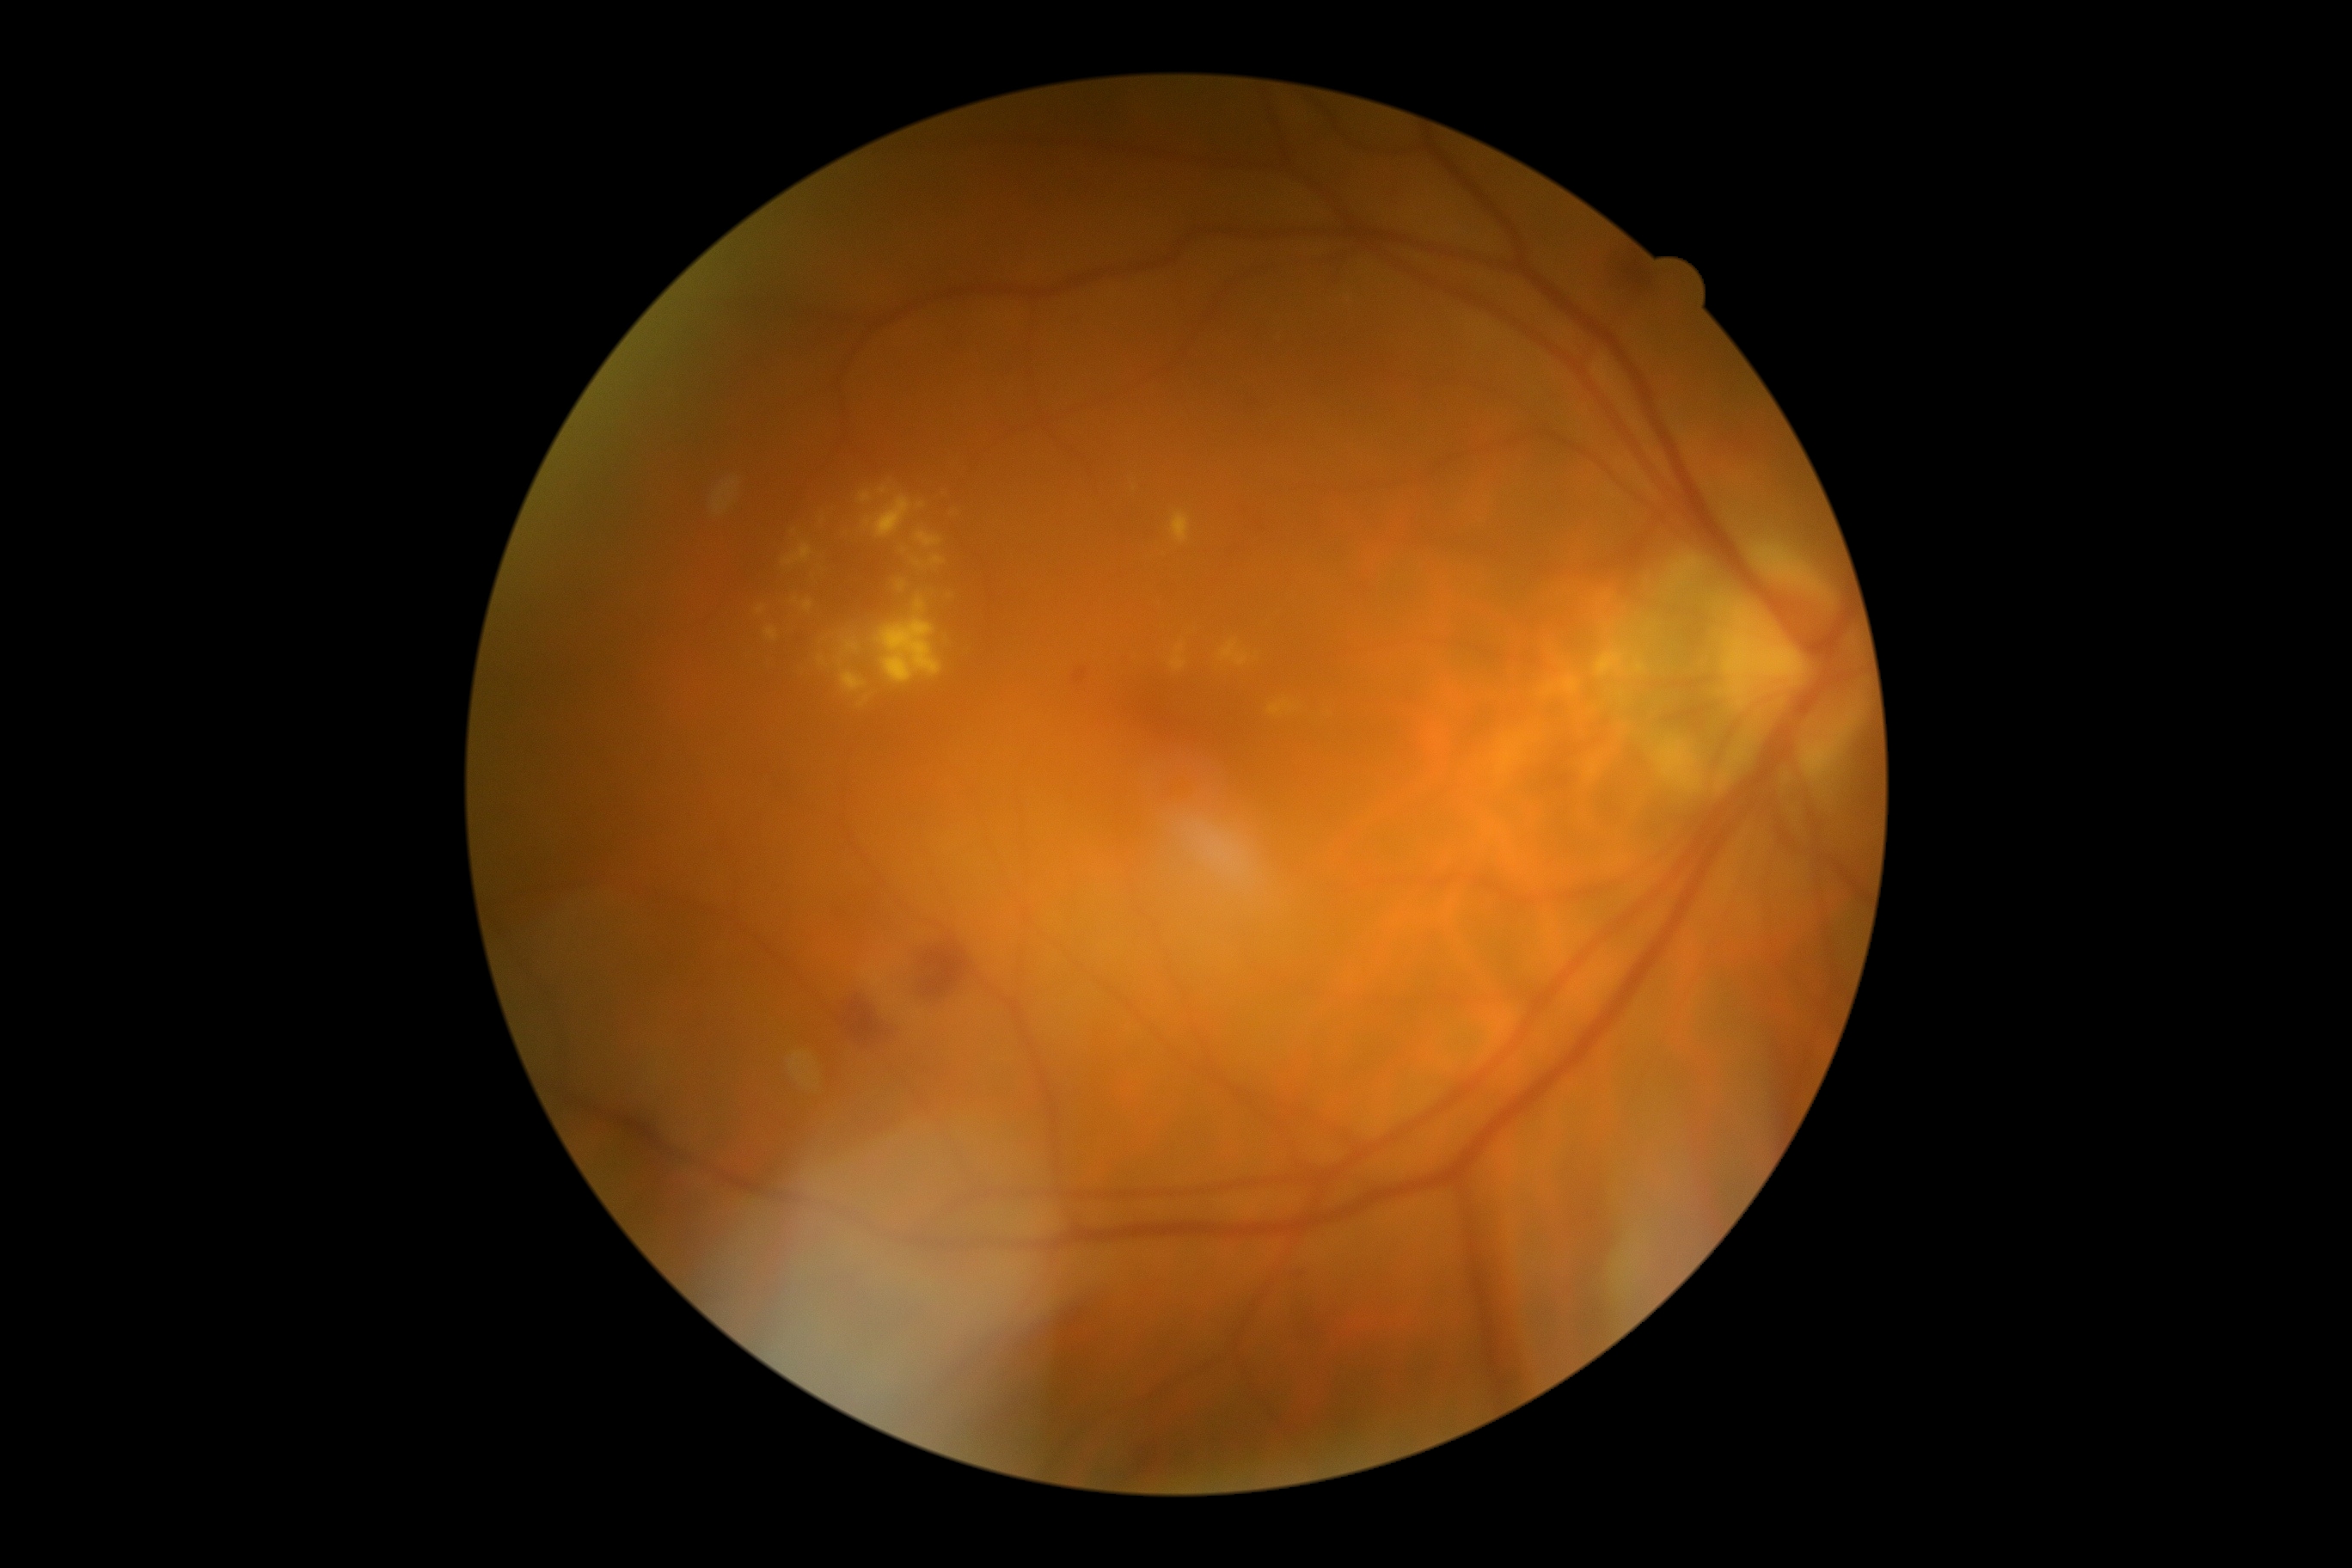
dr_grade: moderate NPDR (grade 2)